45° field of view — 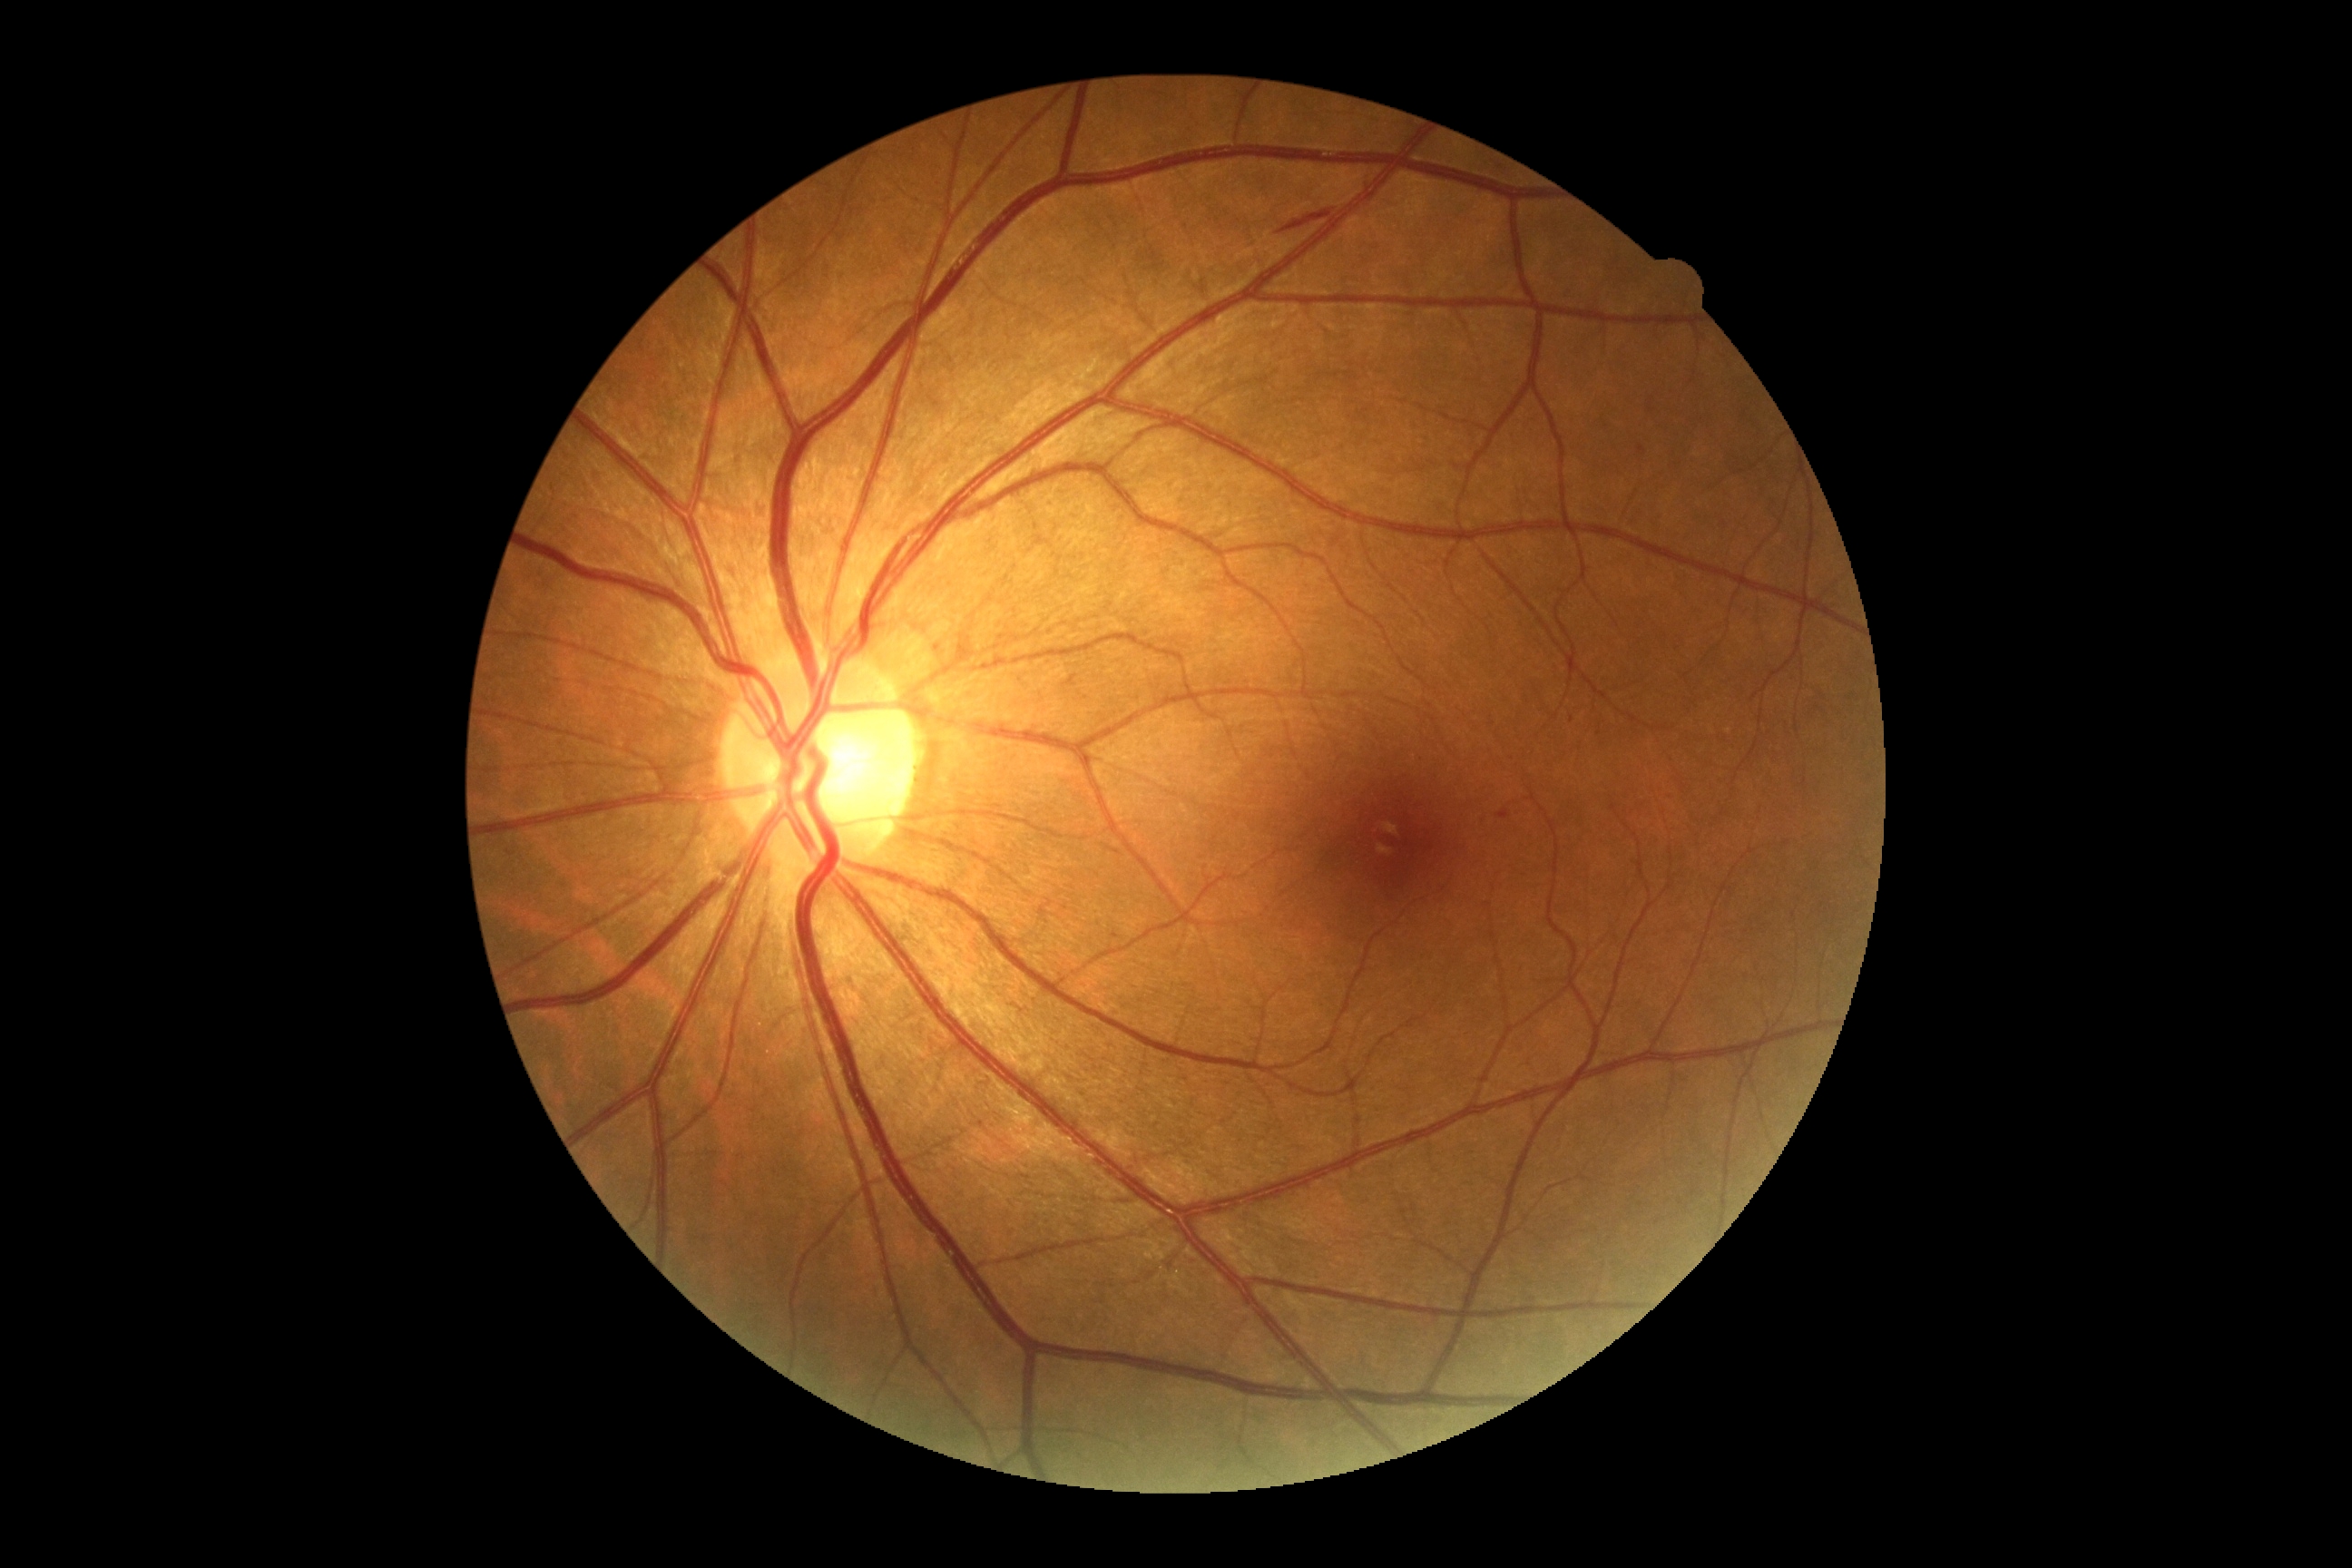

Diabetic retinopathy (DR) is 2.